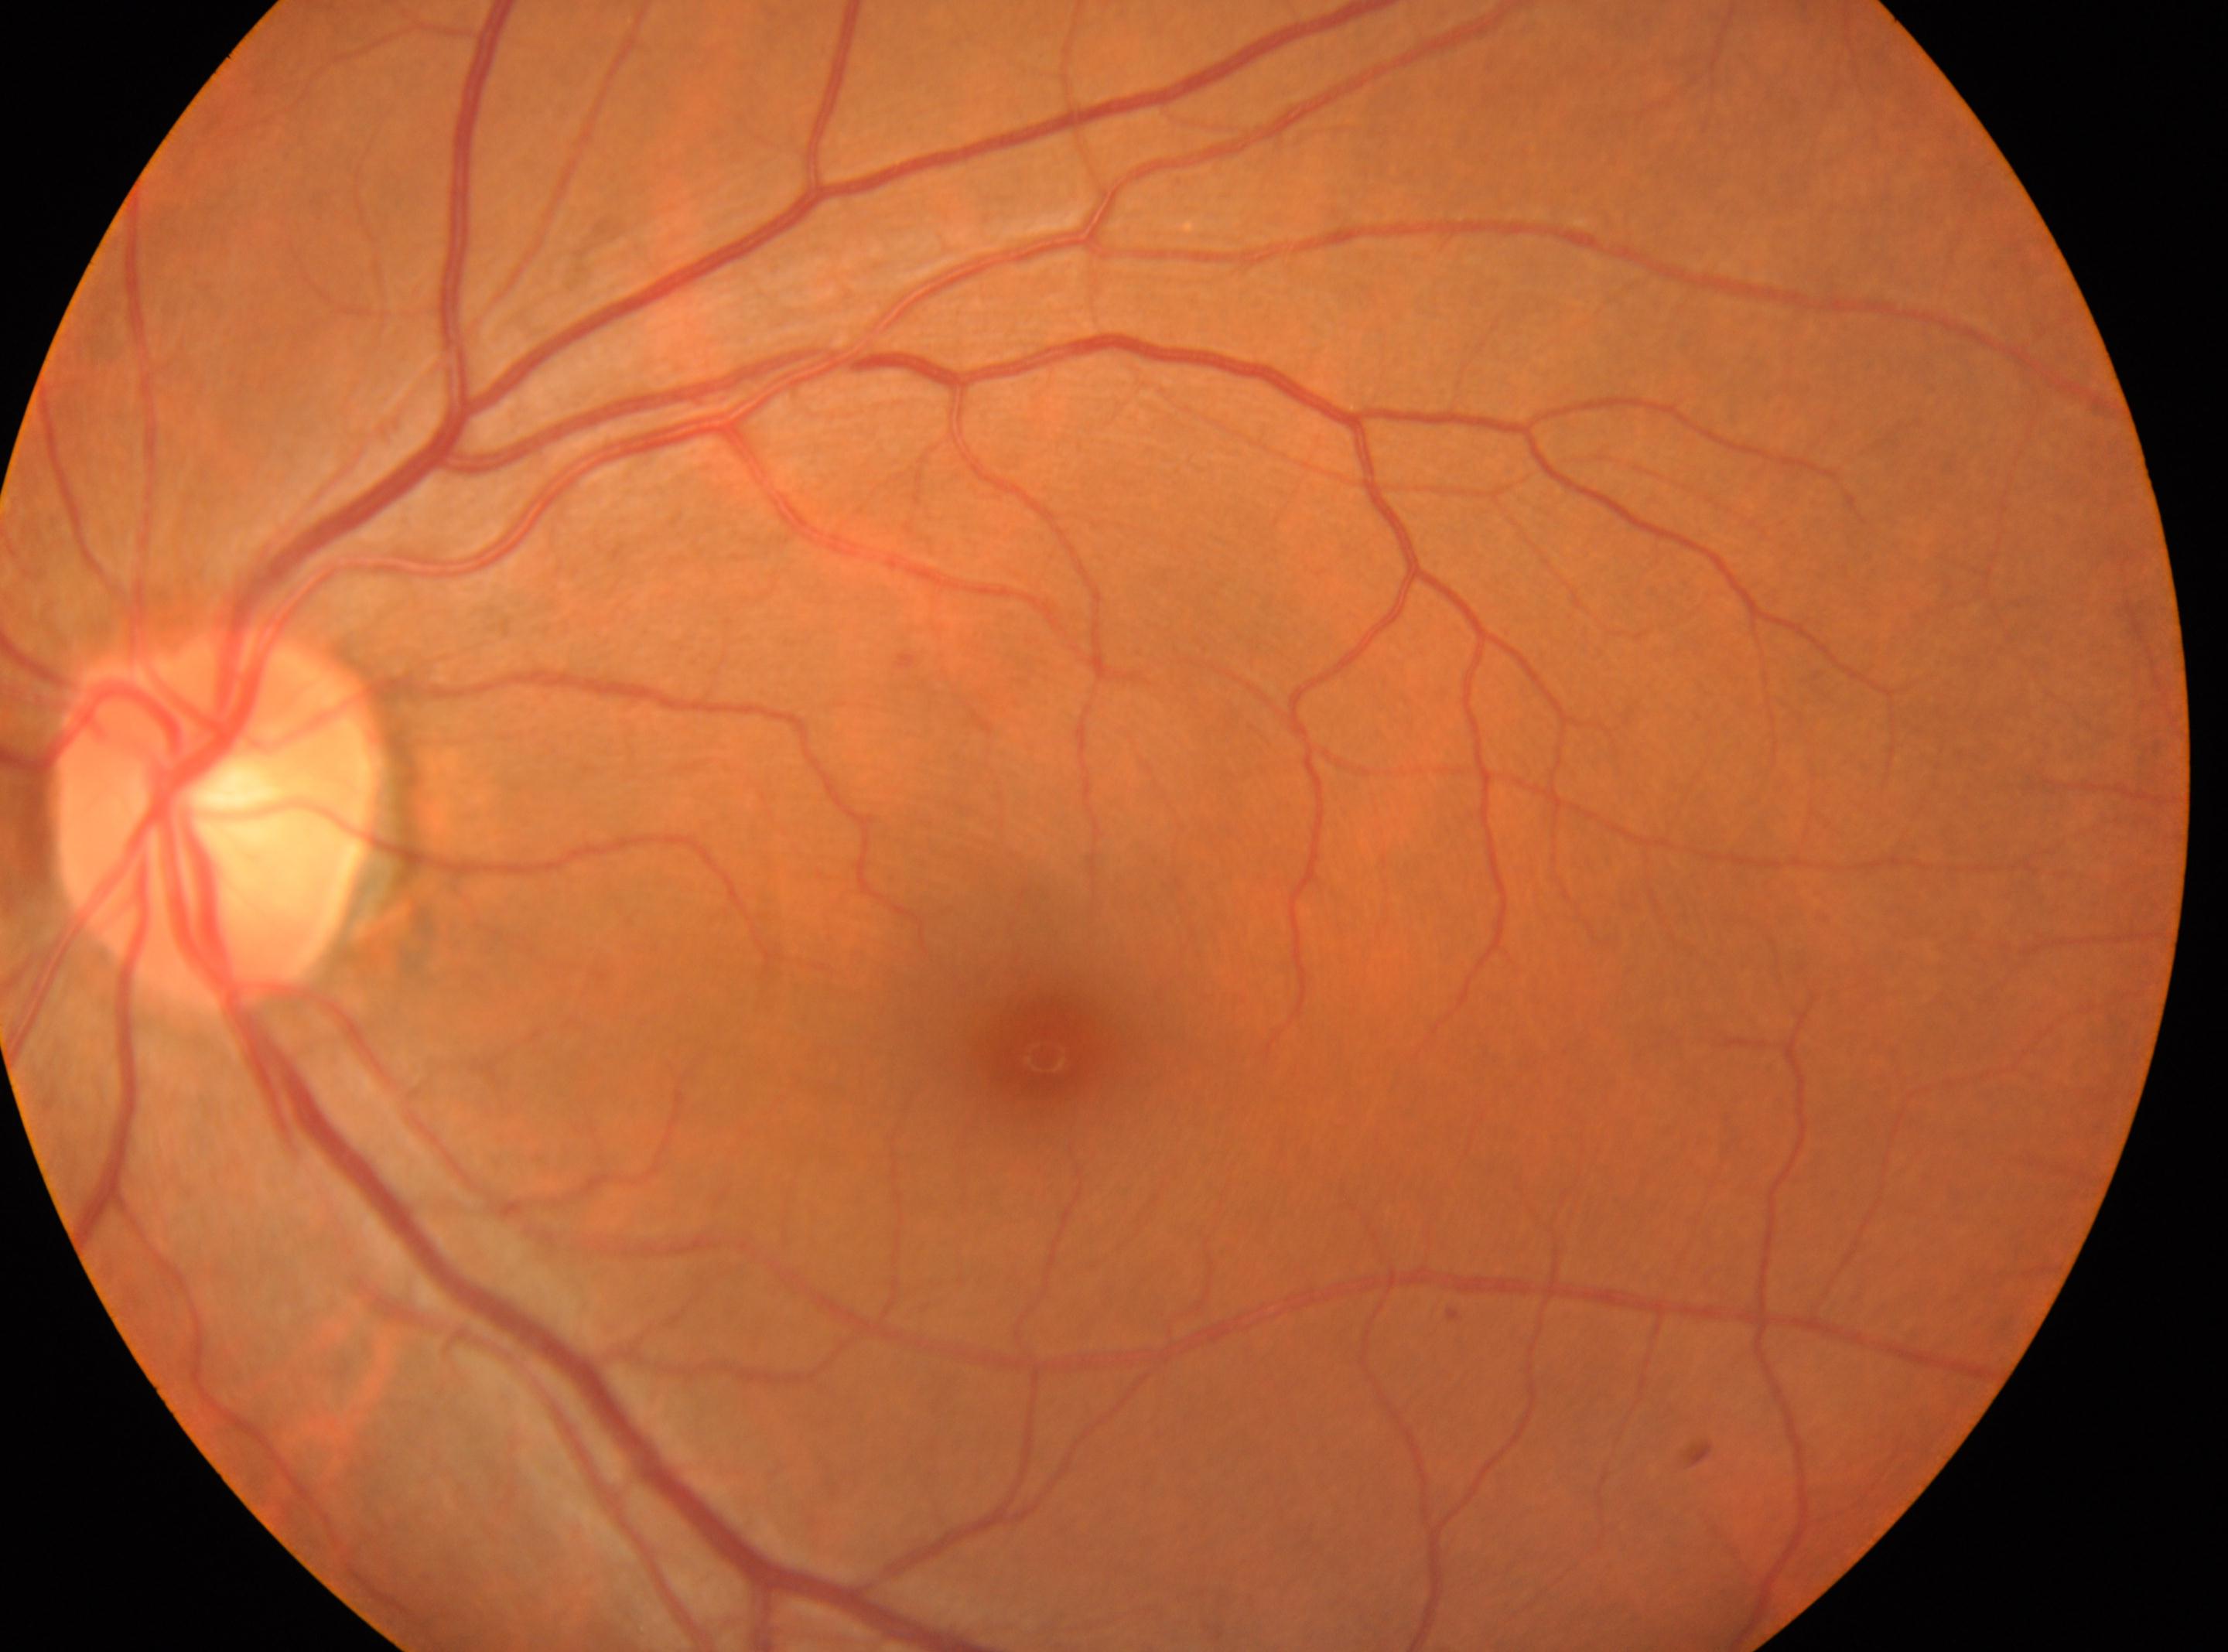

Q: What is the laterality?
A: left
Q: Diabetic retinopathy severity?
A: grade 0
Q: Locate the optic disc.
A: (212, 813)
Q: Fovea center?
A: (1043, 1056)